45° field of view.
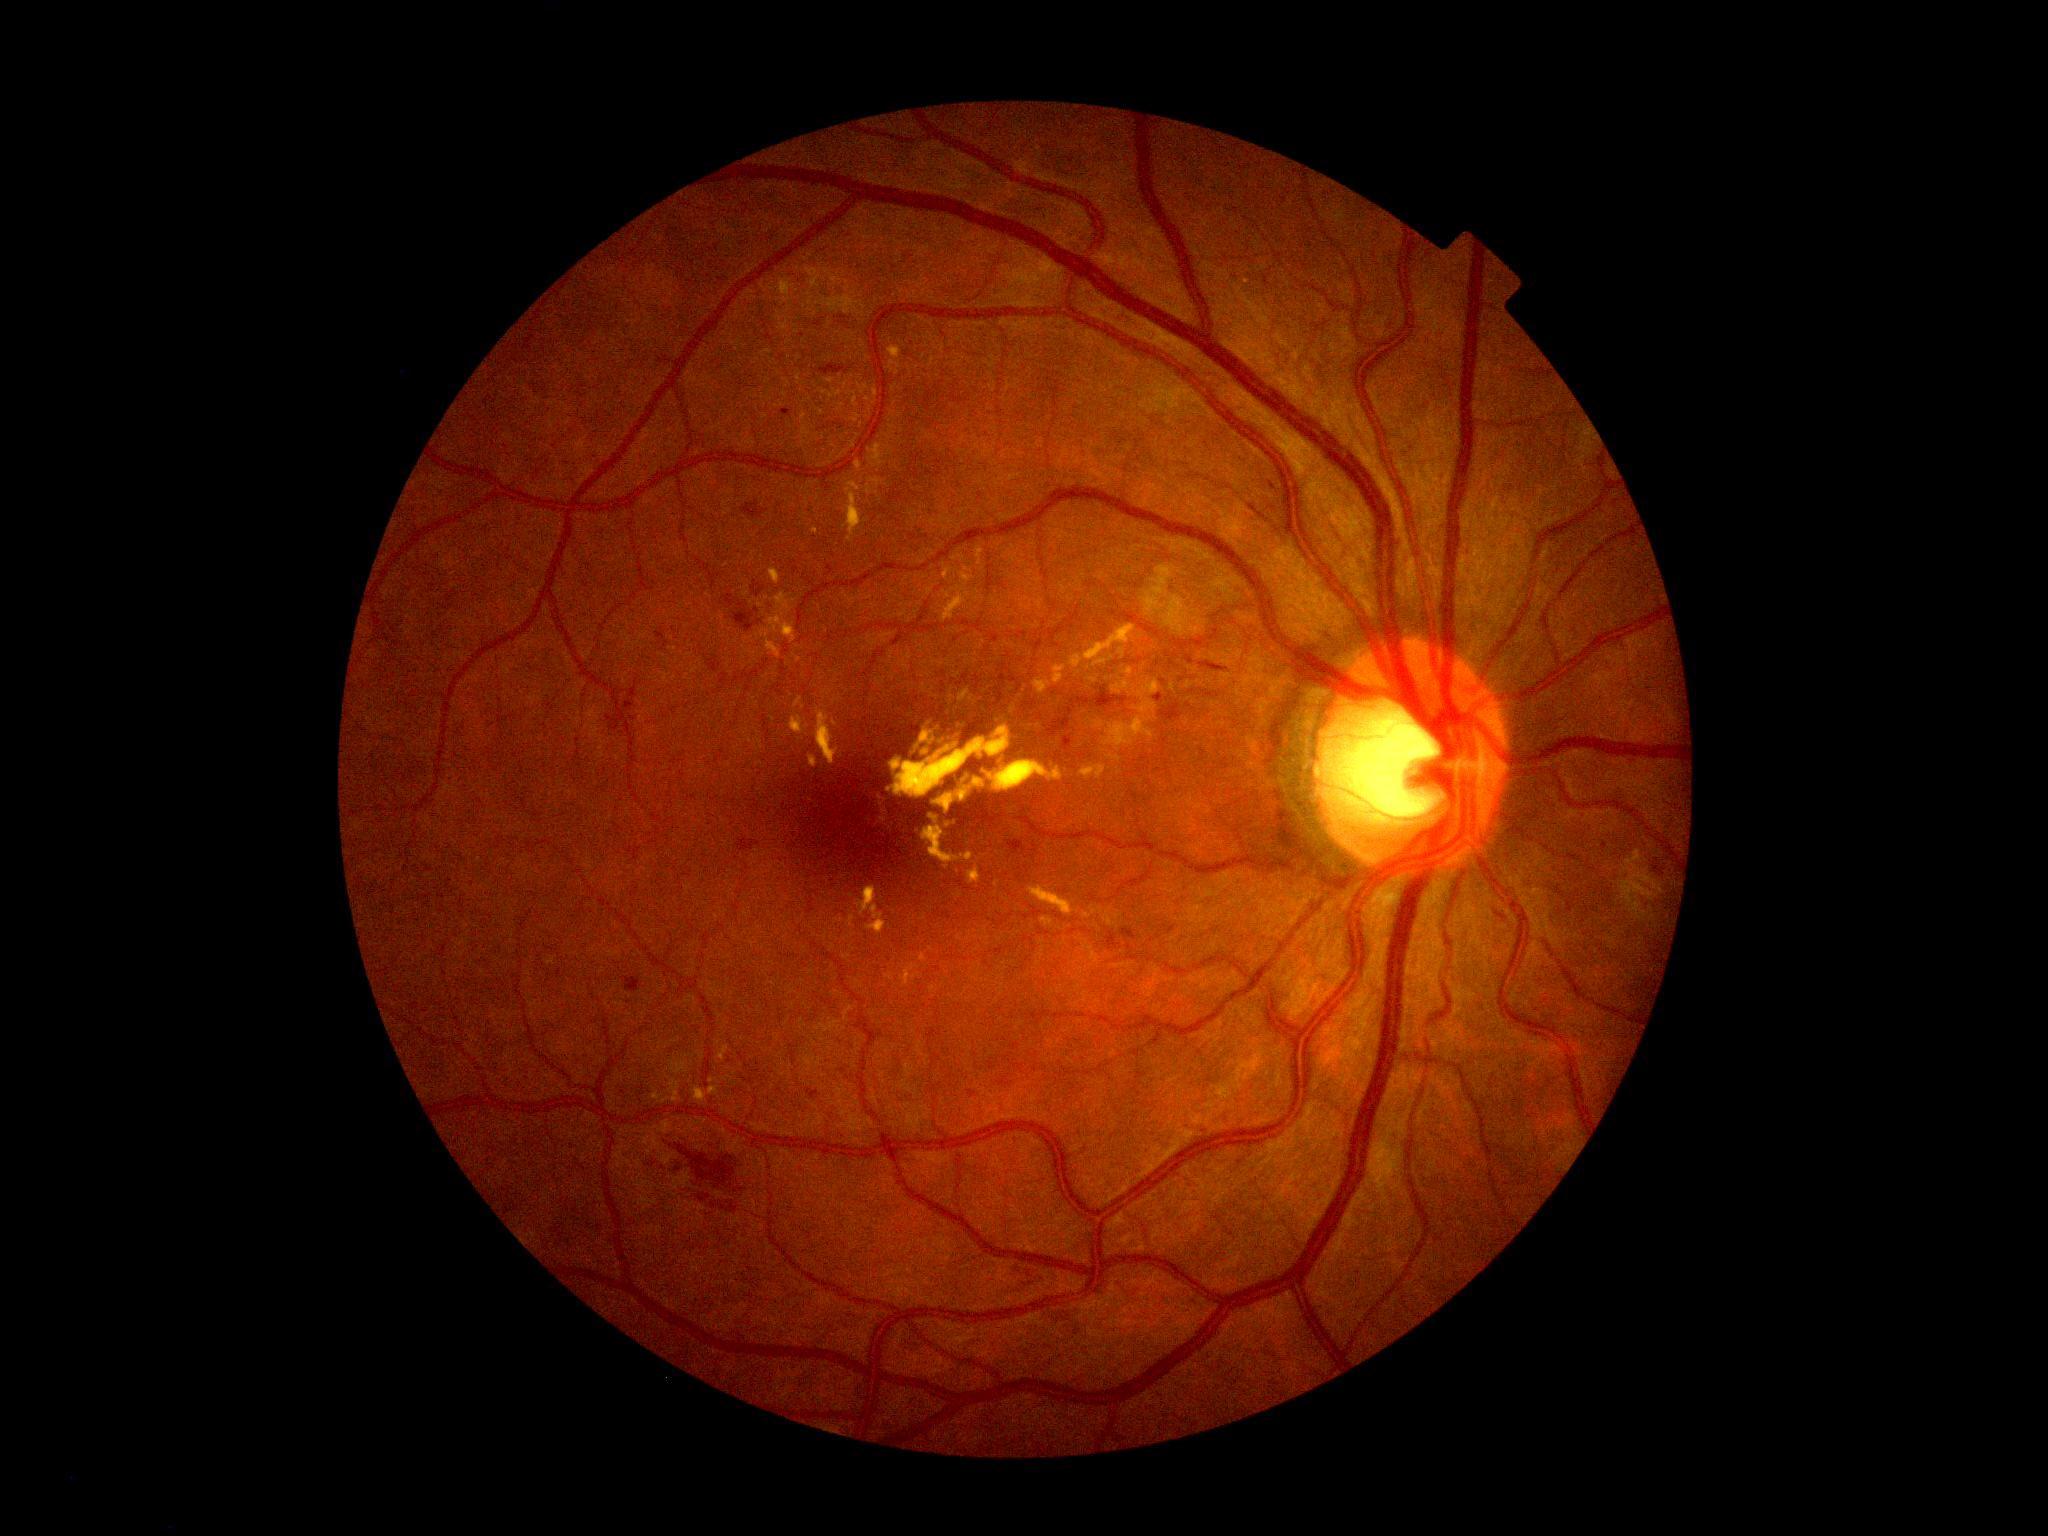

DR stage@moderate non-proliferative diabetic retinopathy (grade 2); DR class@non-proliferative diabetic retinopathy.